Nonmydriatic fundus photograph: 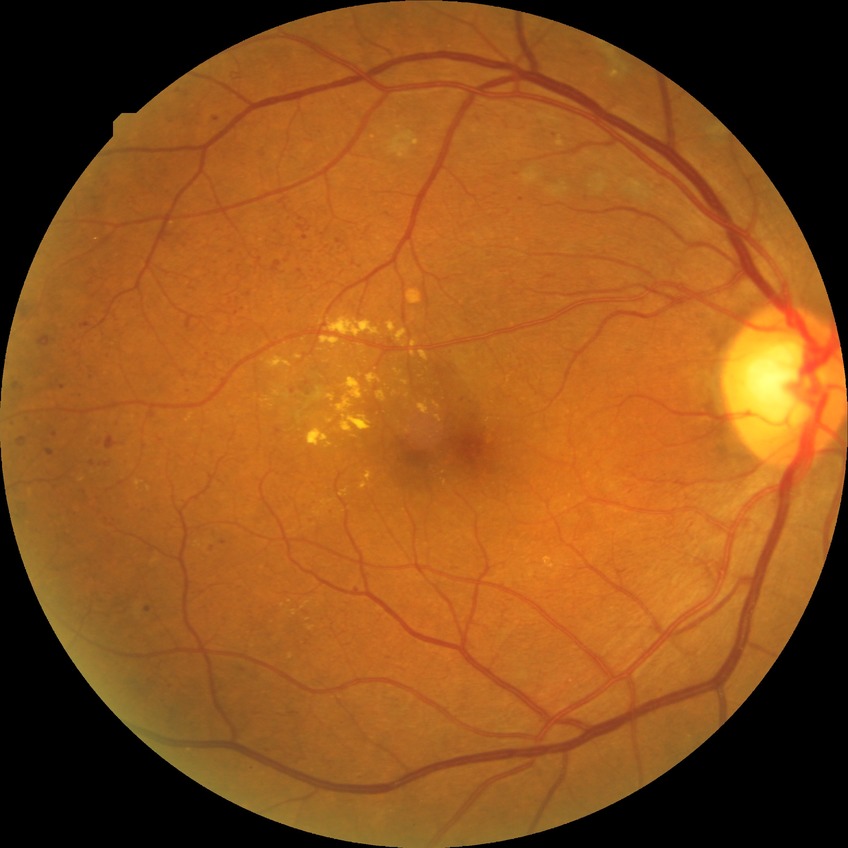

Diabetic retinopathy (DR) is PDR (proliferative diabetic retinopathy).